Camera: Natus RetCam Envision (130° FOV) · wide-field fundus image from infant ROP screening.
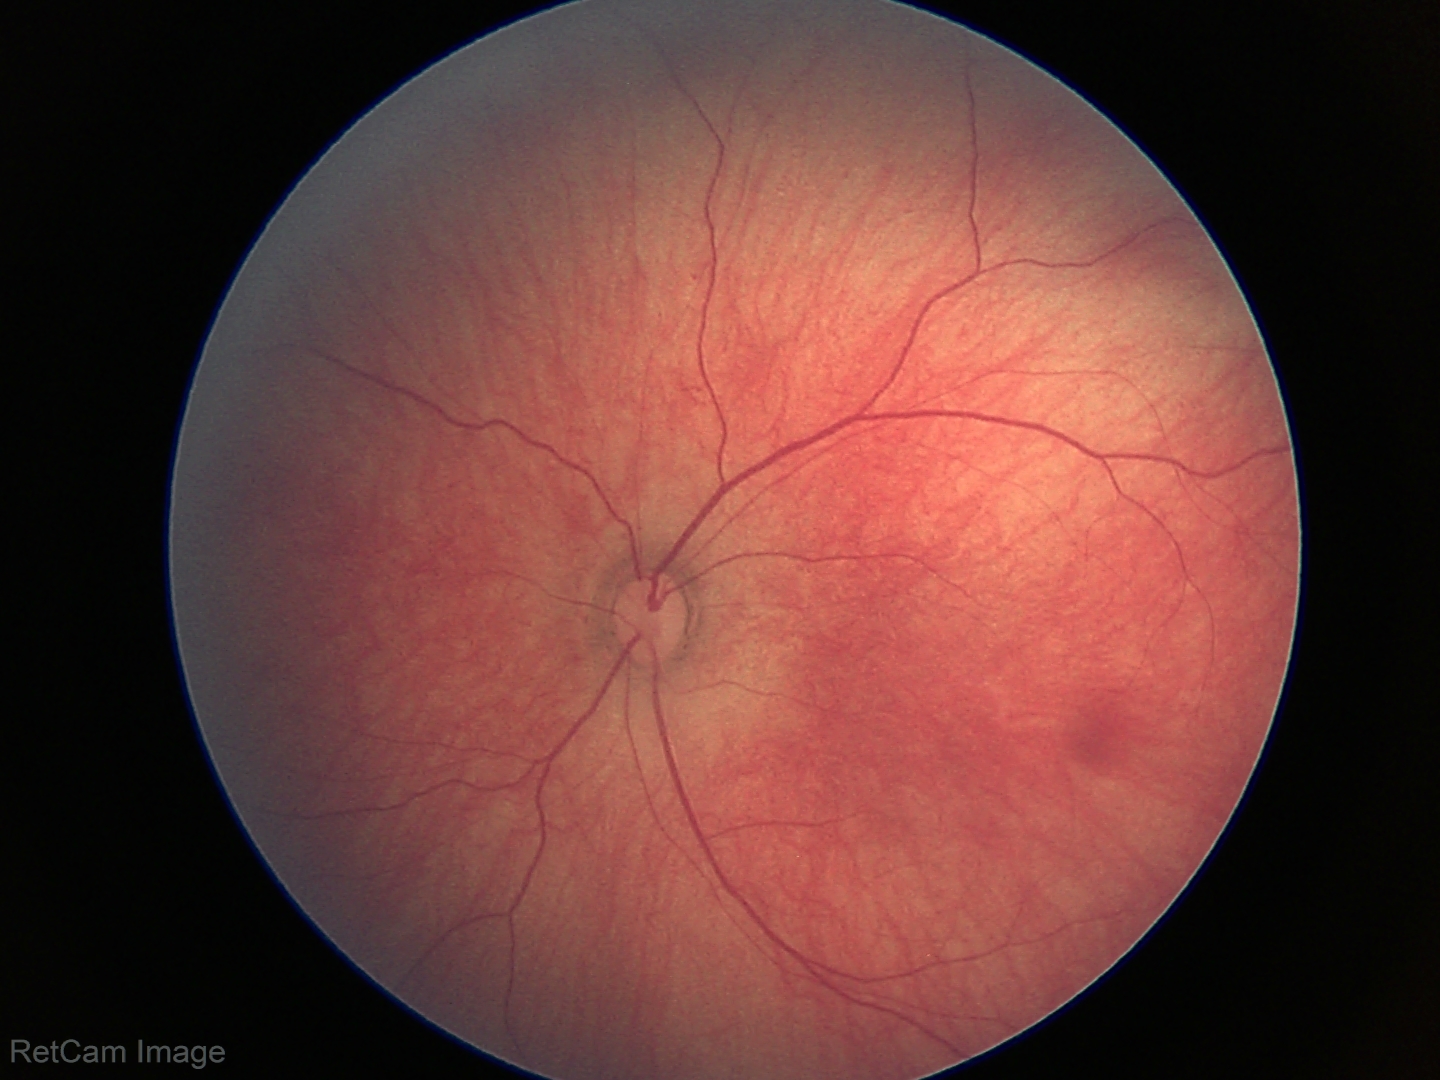 Finding: physiological appearance.